Posterior pole field covering the optic disc and macula:
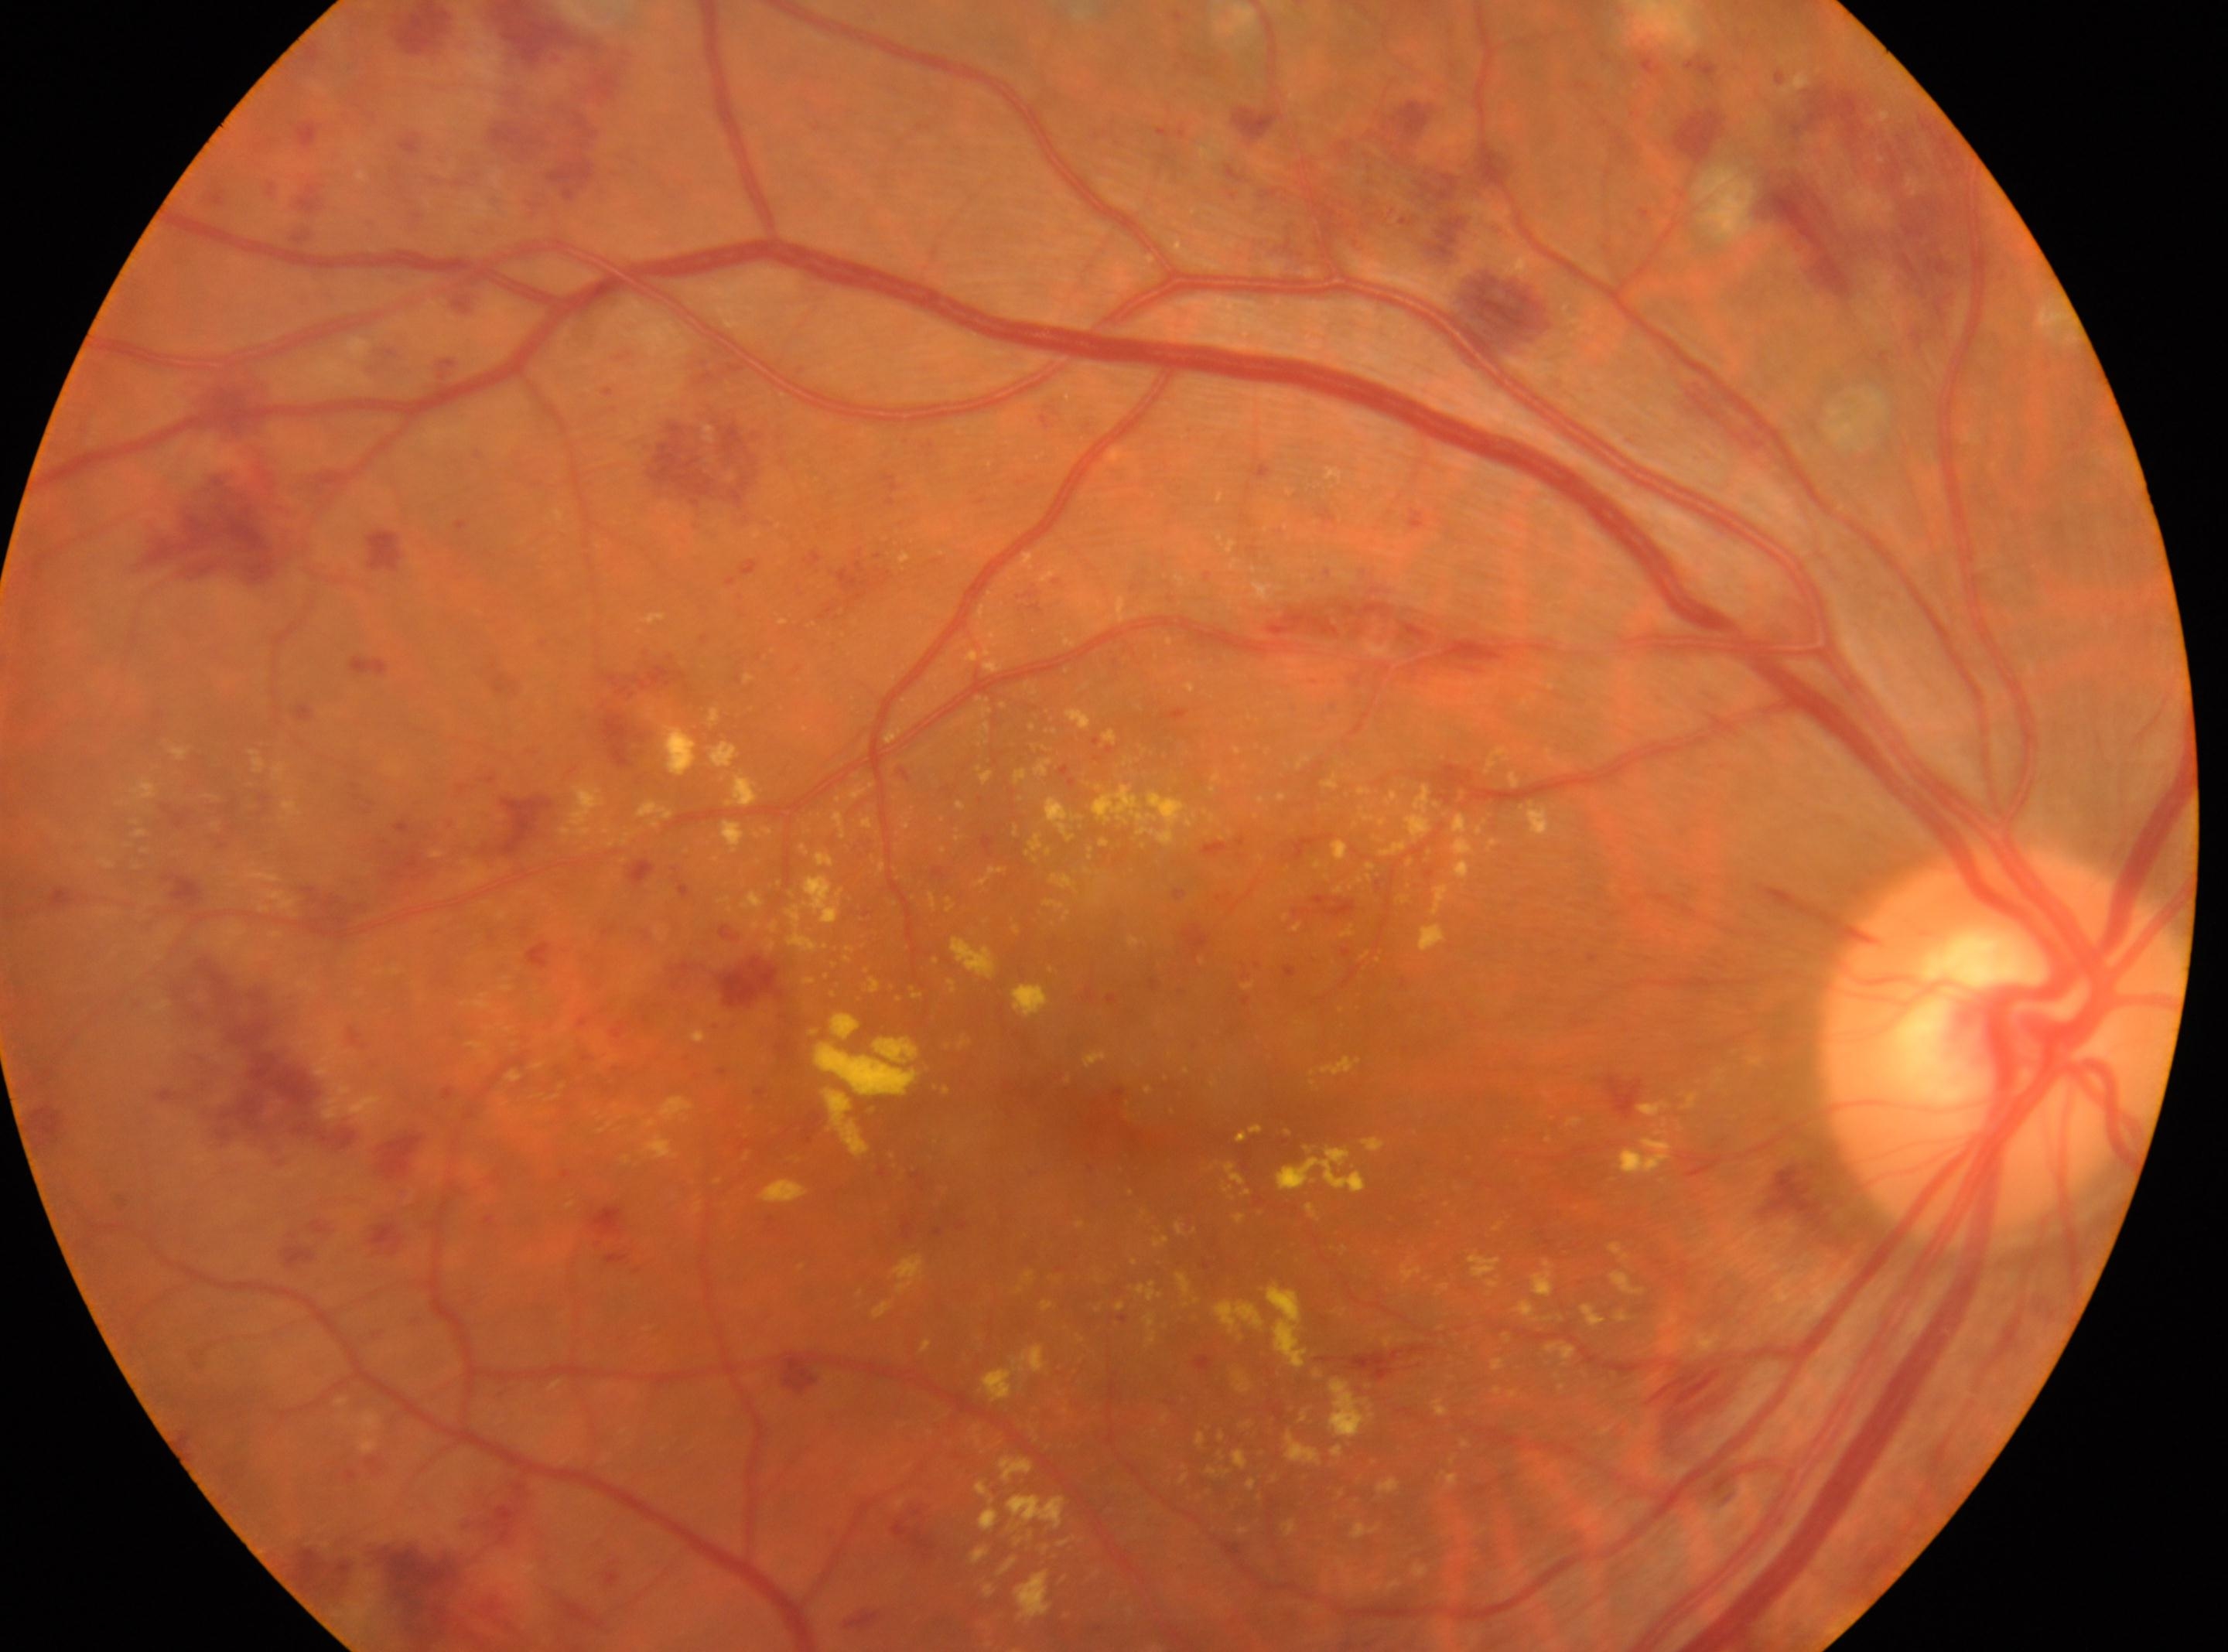 Diabetic retinopathy (DR) is DR with laser spots or scars.
The optic disc is at (2002, 1048).
Macula center: (1102, 1108).
The image shows the oculus dexter.